45° field of view, color fundus photograph:
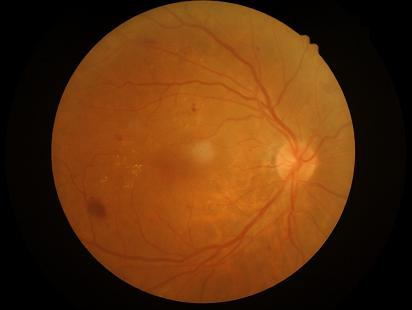 Image quality is adequate for diagnostic use.
Contrast is good.
Even illumination with no color cast.
Image is sharp throughout the field.